848 by 848 pixels. No pharmacologic dilation. Fundus photo. Camera: NIDEK AFC-230.
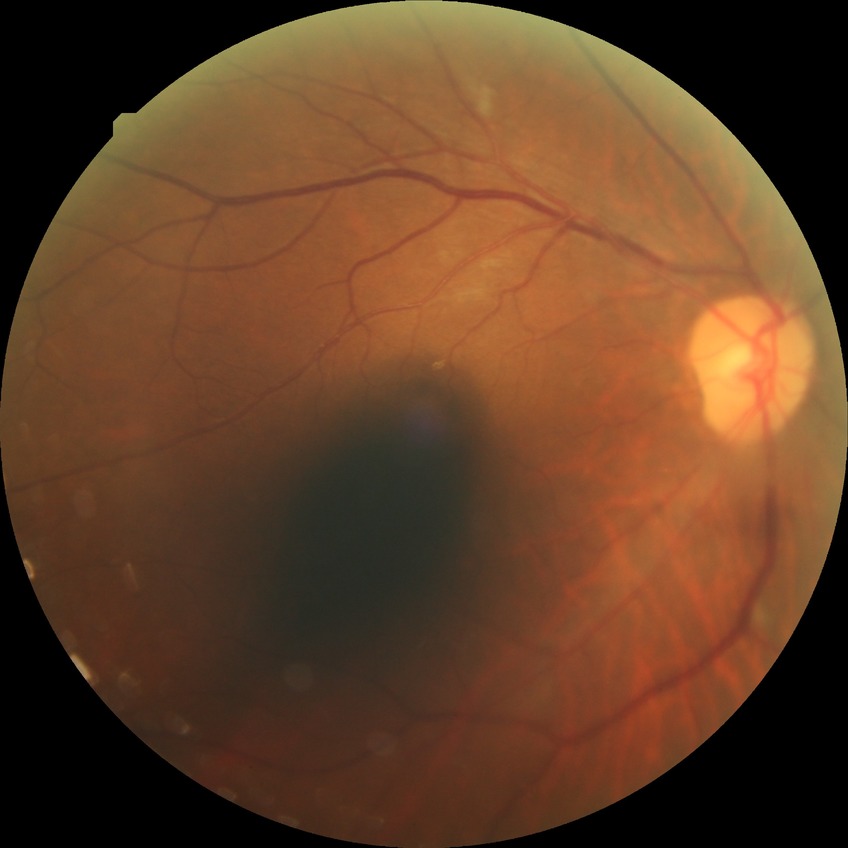

DR grade is PPDR.